Mydriatic (tropicamide phenylephrine 1.0%).
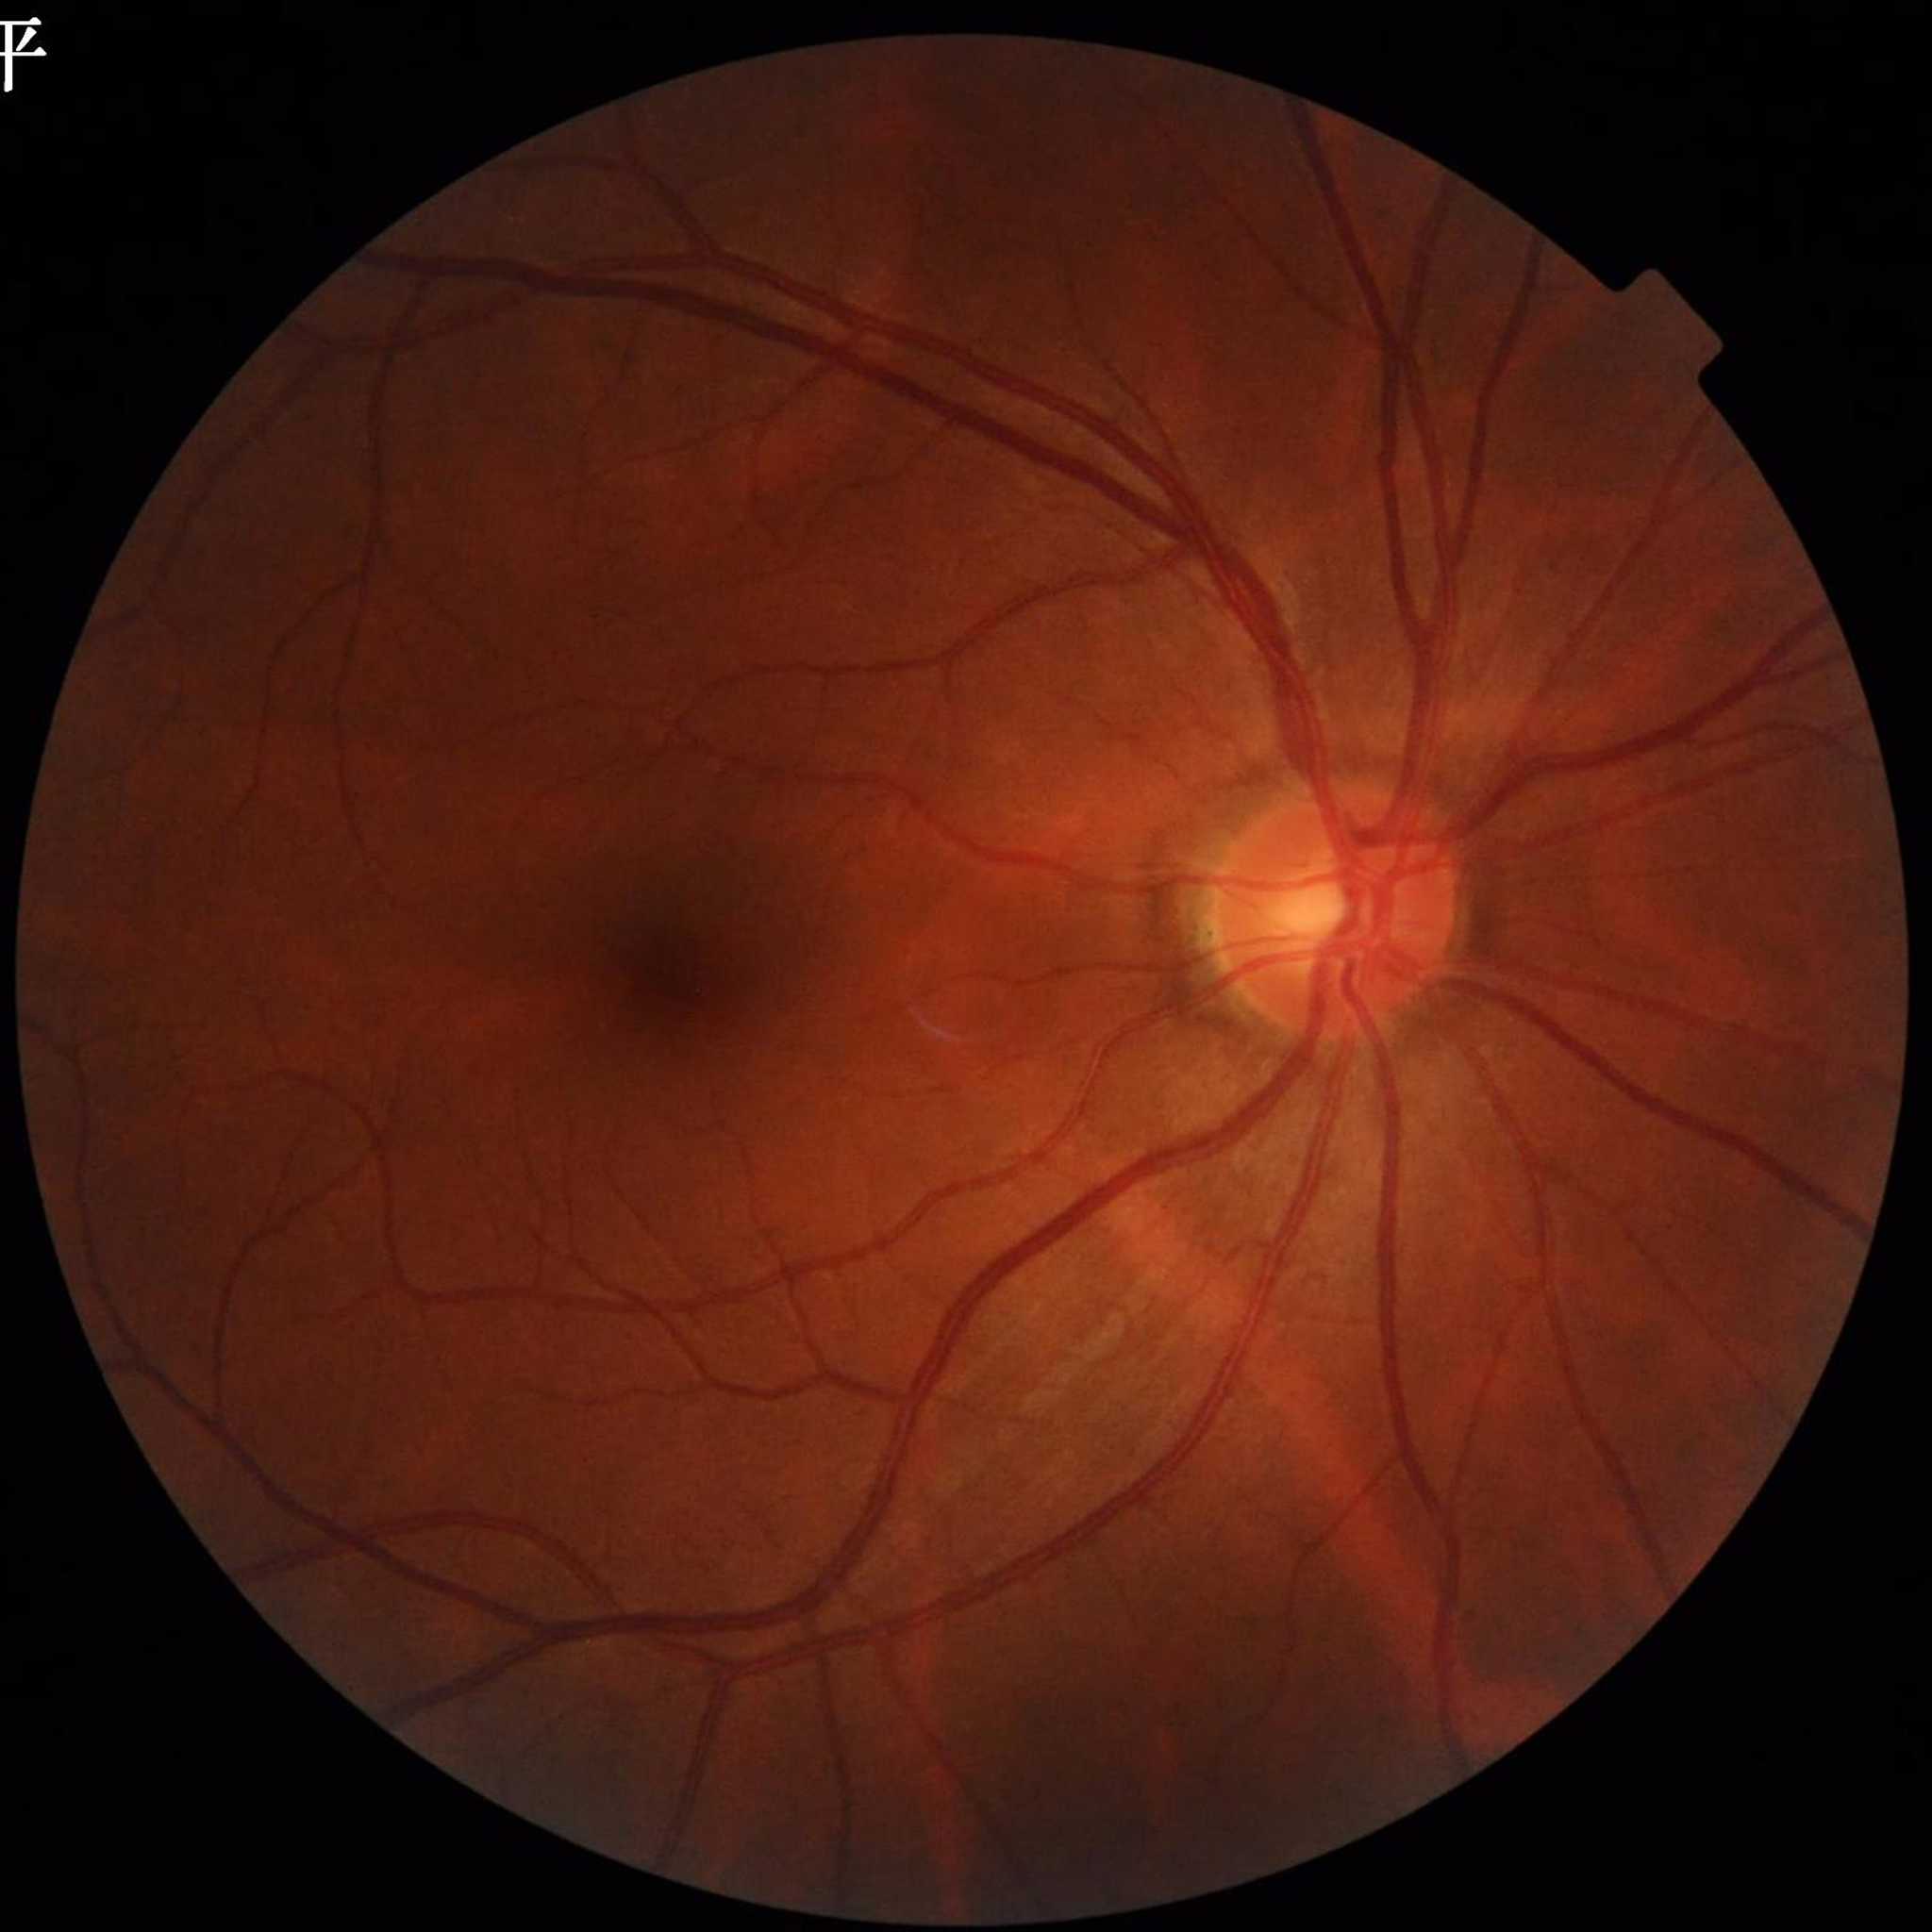
{
  "diagnosis": "glaucoma",
  "image_quality": "satisfactory"
}